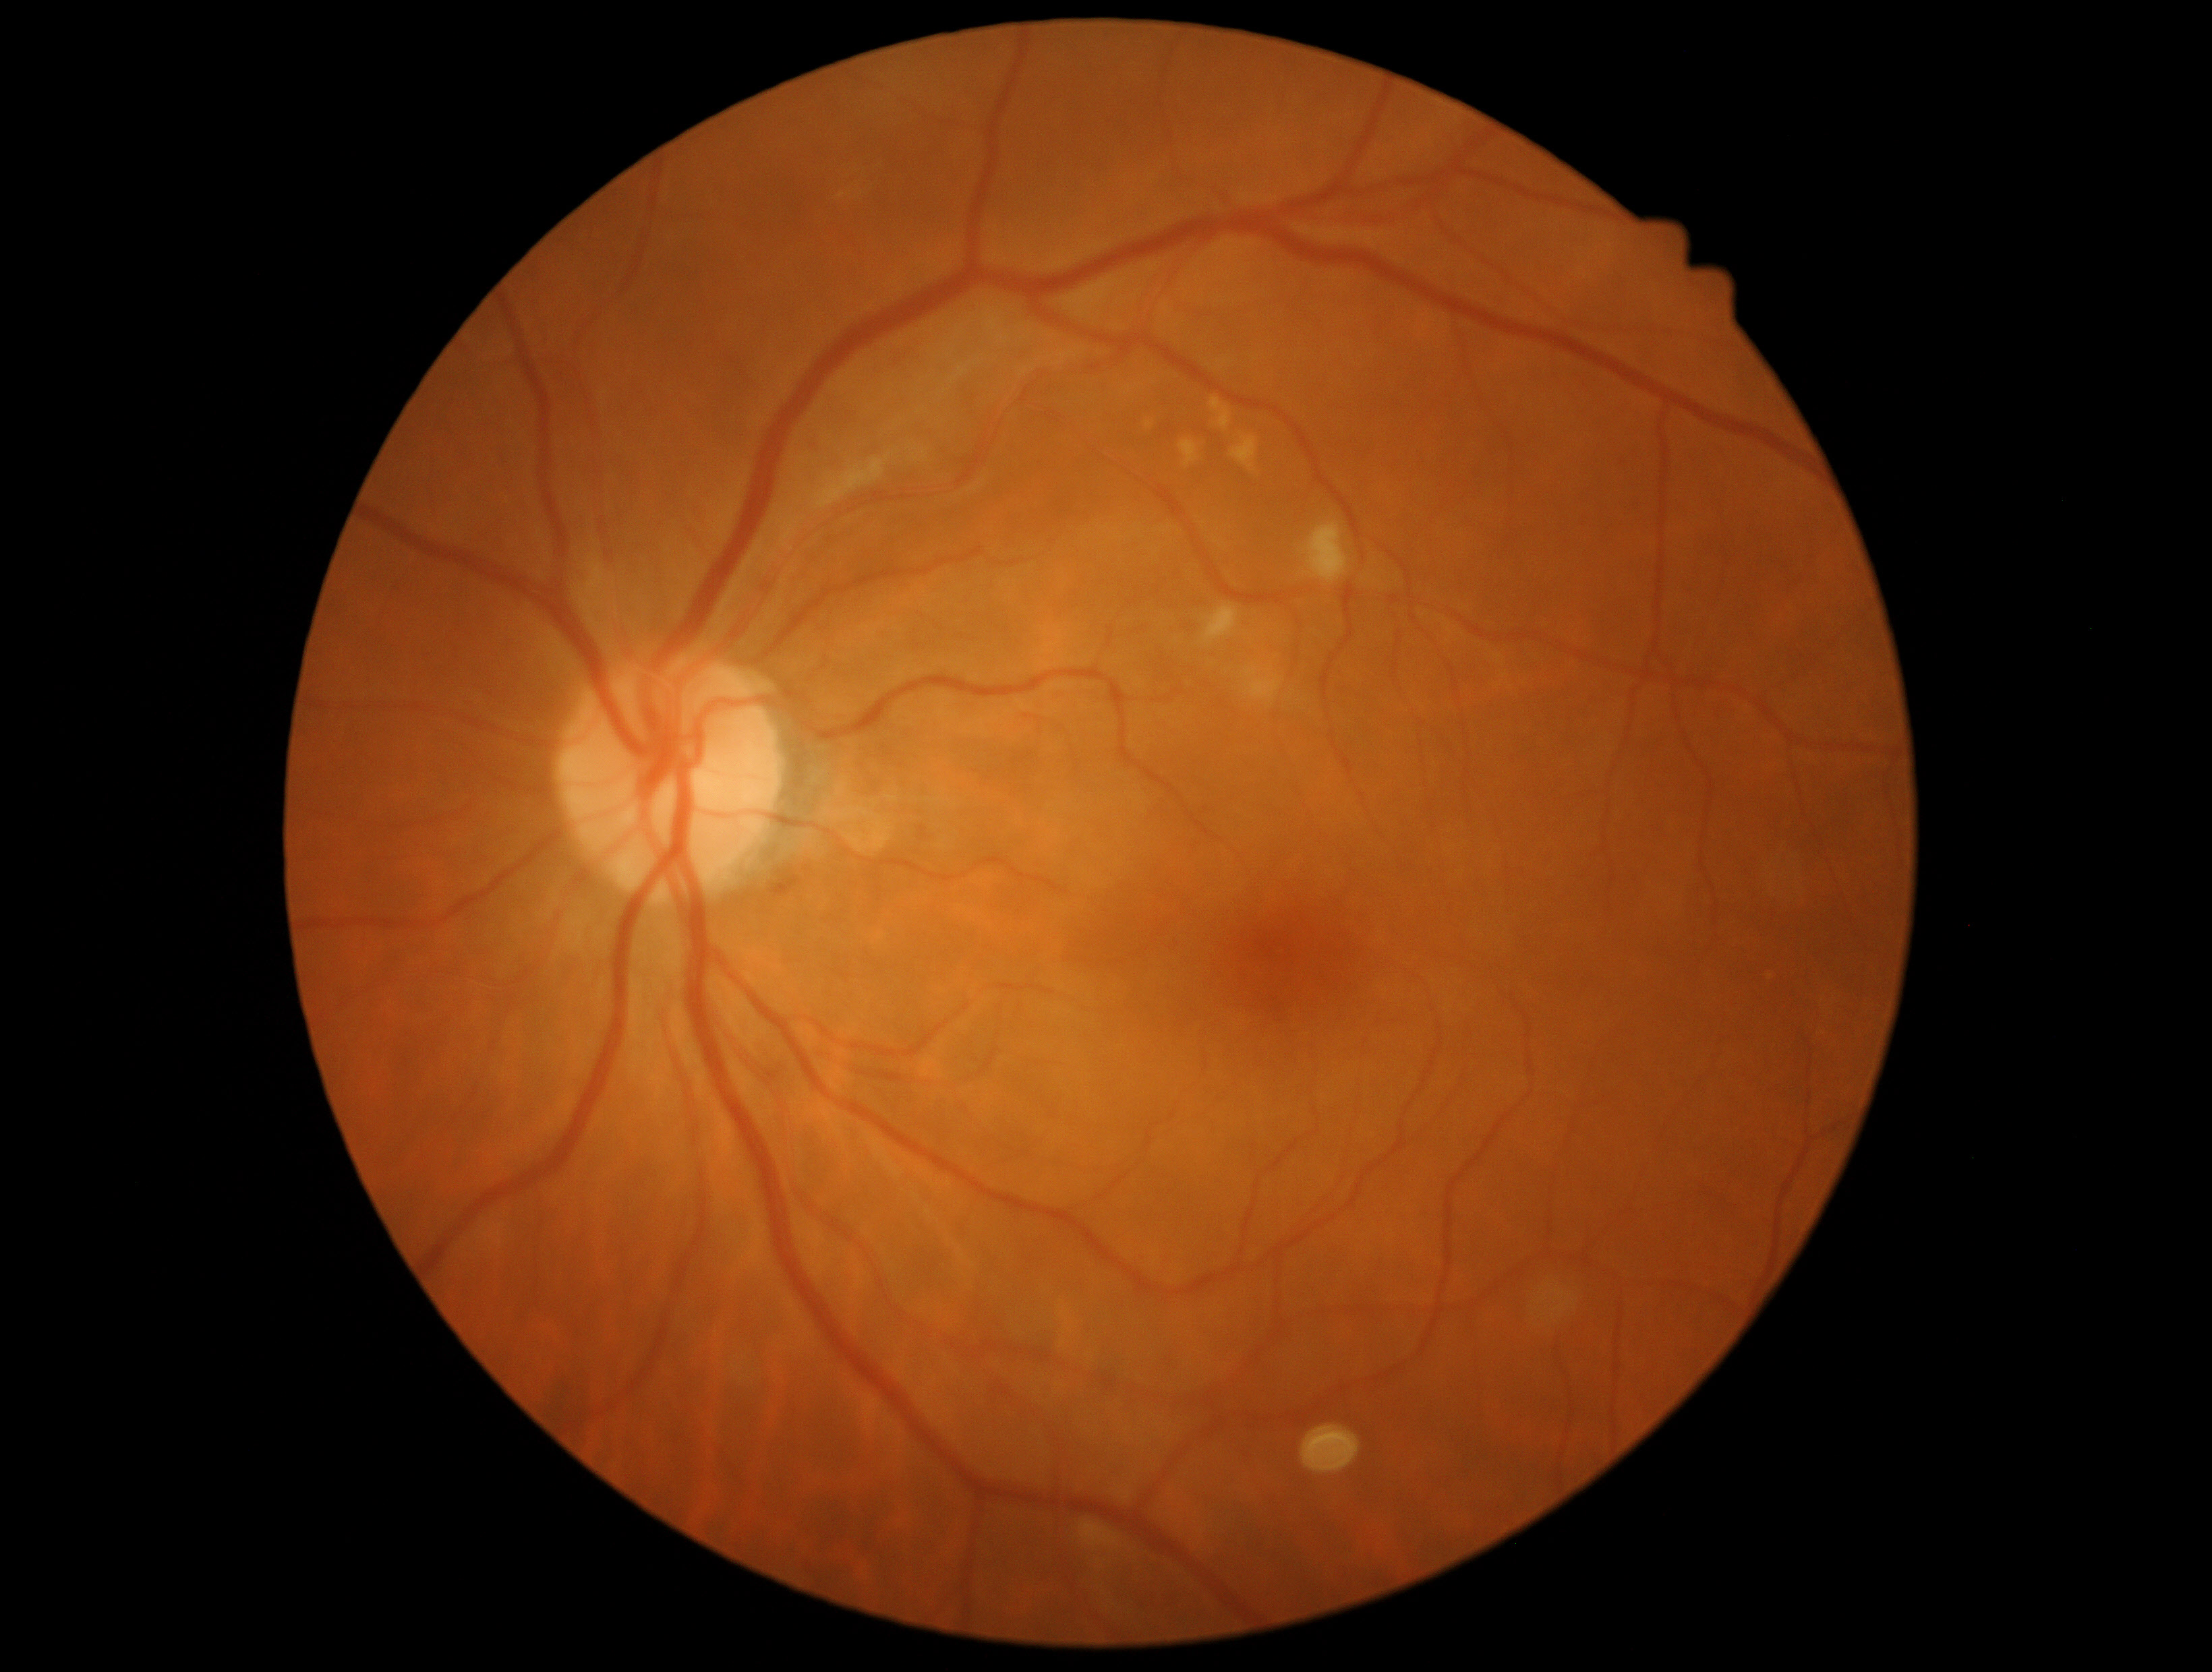

retinopathy grade@2.